Graded on the modified Davis scale; acquired with a NIDEK AFC-230: 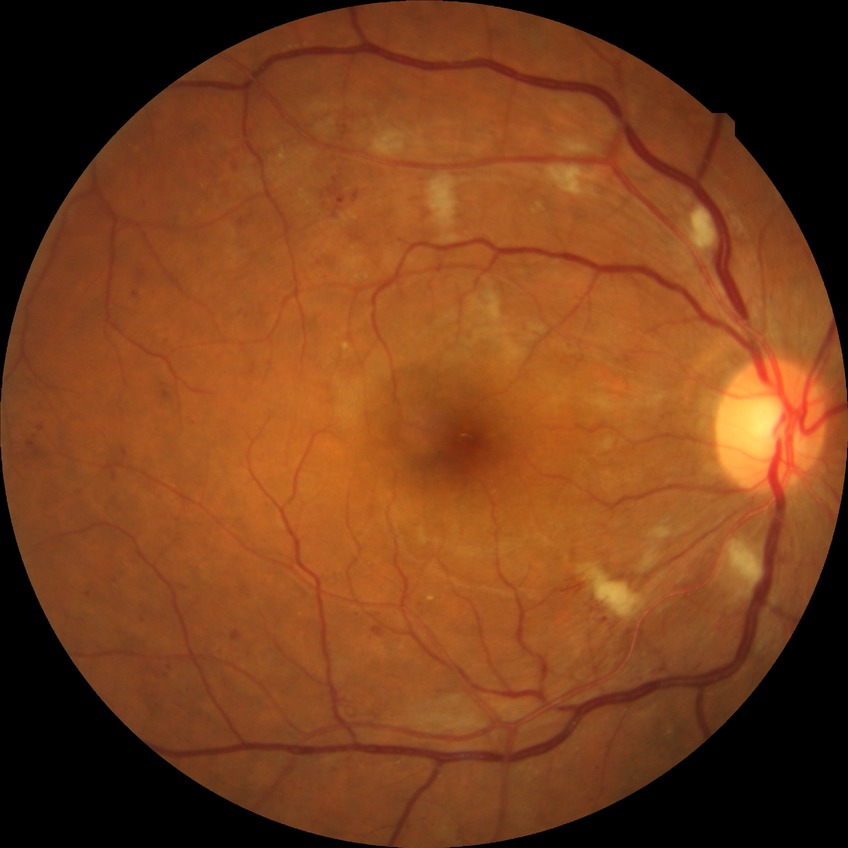 {
  "davis_grade": "PPDR (pre-proliferative diabetic retinopathy)"
}